Wide-field fundus image from infant ROP screening.
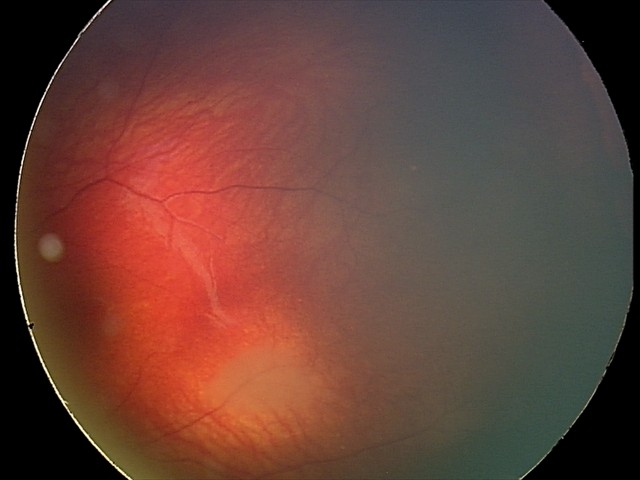

Diagnosis from this screening exam: retinal astrocytic hamartoma.